45-degree field of view. 848 by 848 pixels. Posterior pole photograph.
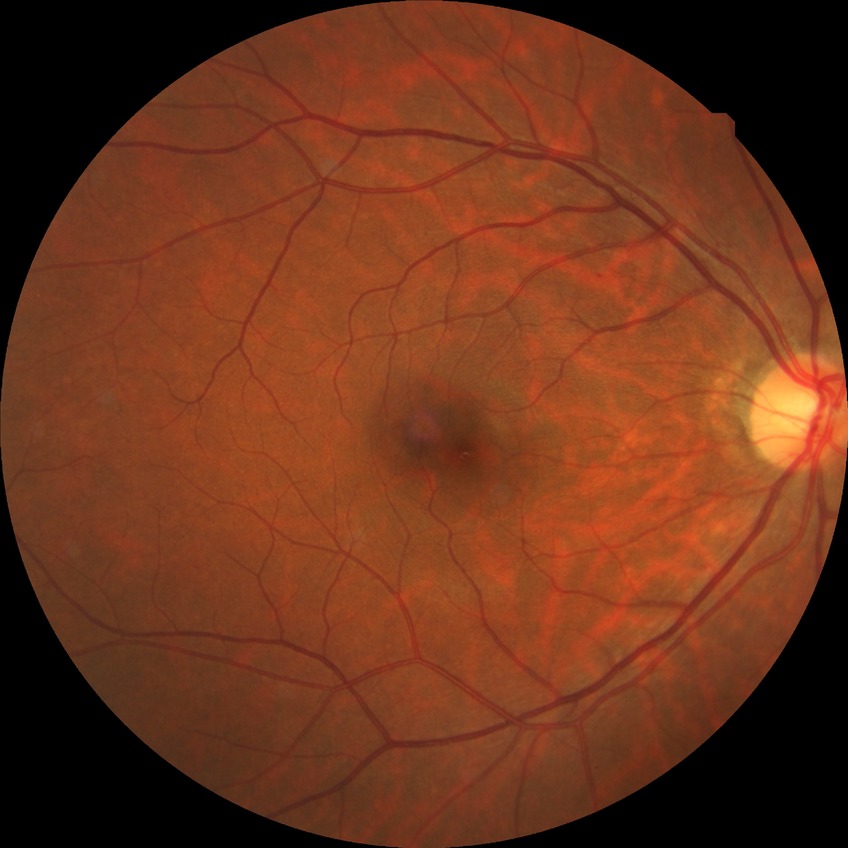

Annotations:
- diabetic retinopathy severity — no diabetic retinopathy